Handheld portable fundus camera image; image size 2212x1659:
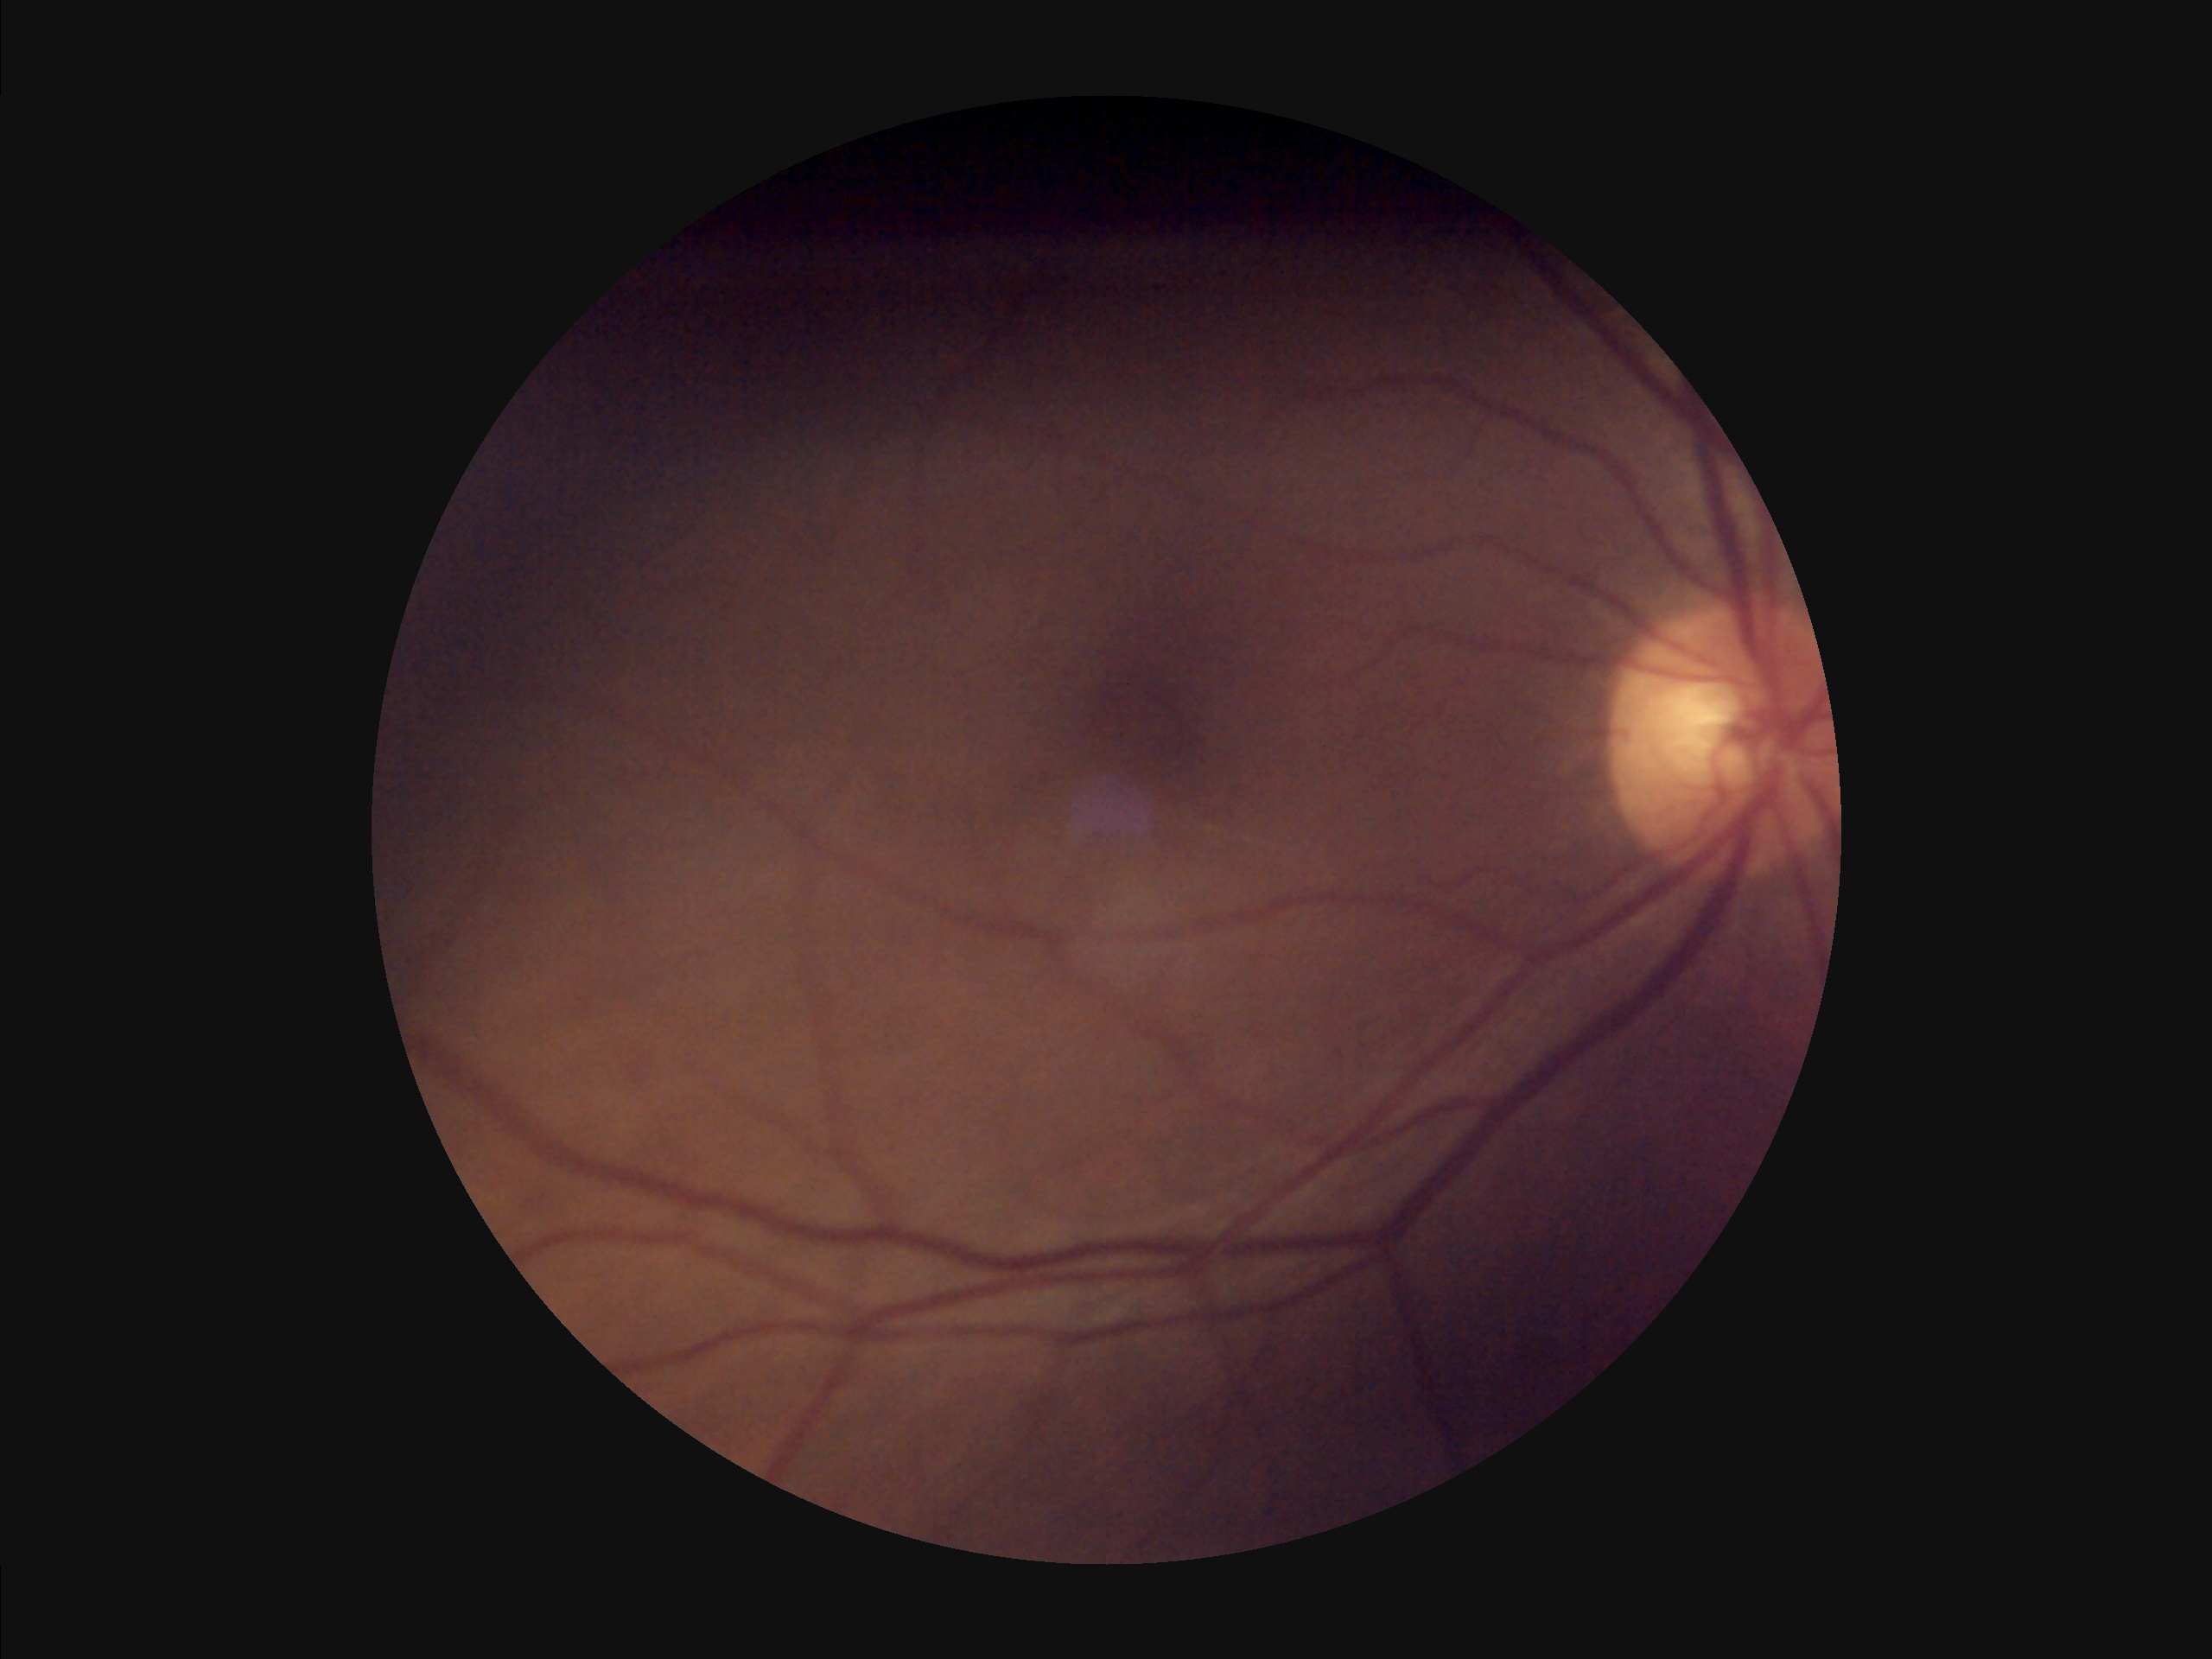
Contrast is low. No noticeable blur. Illumination and color are suboptimal. Image quality is inadequate for diagnostic use.